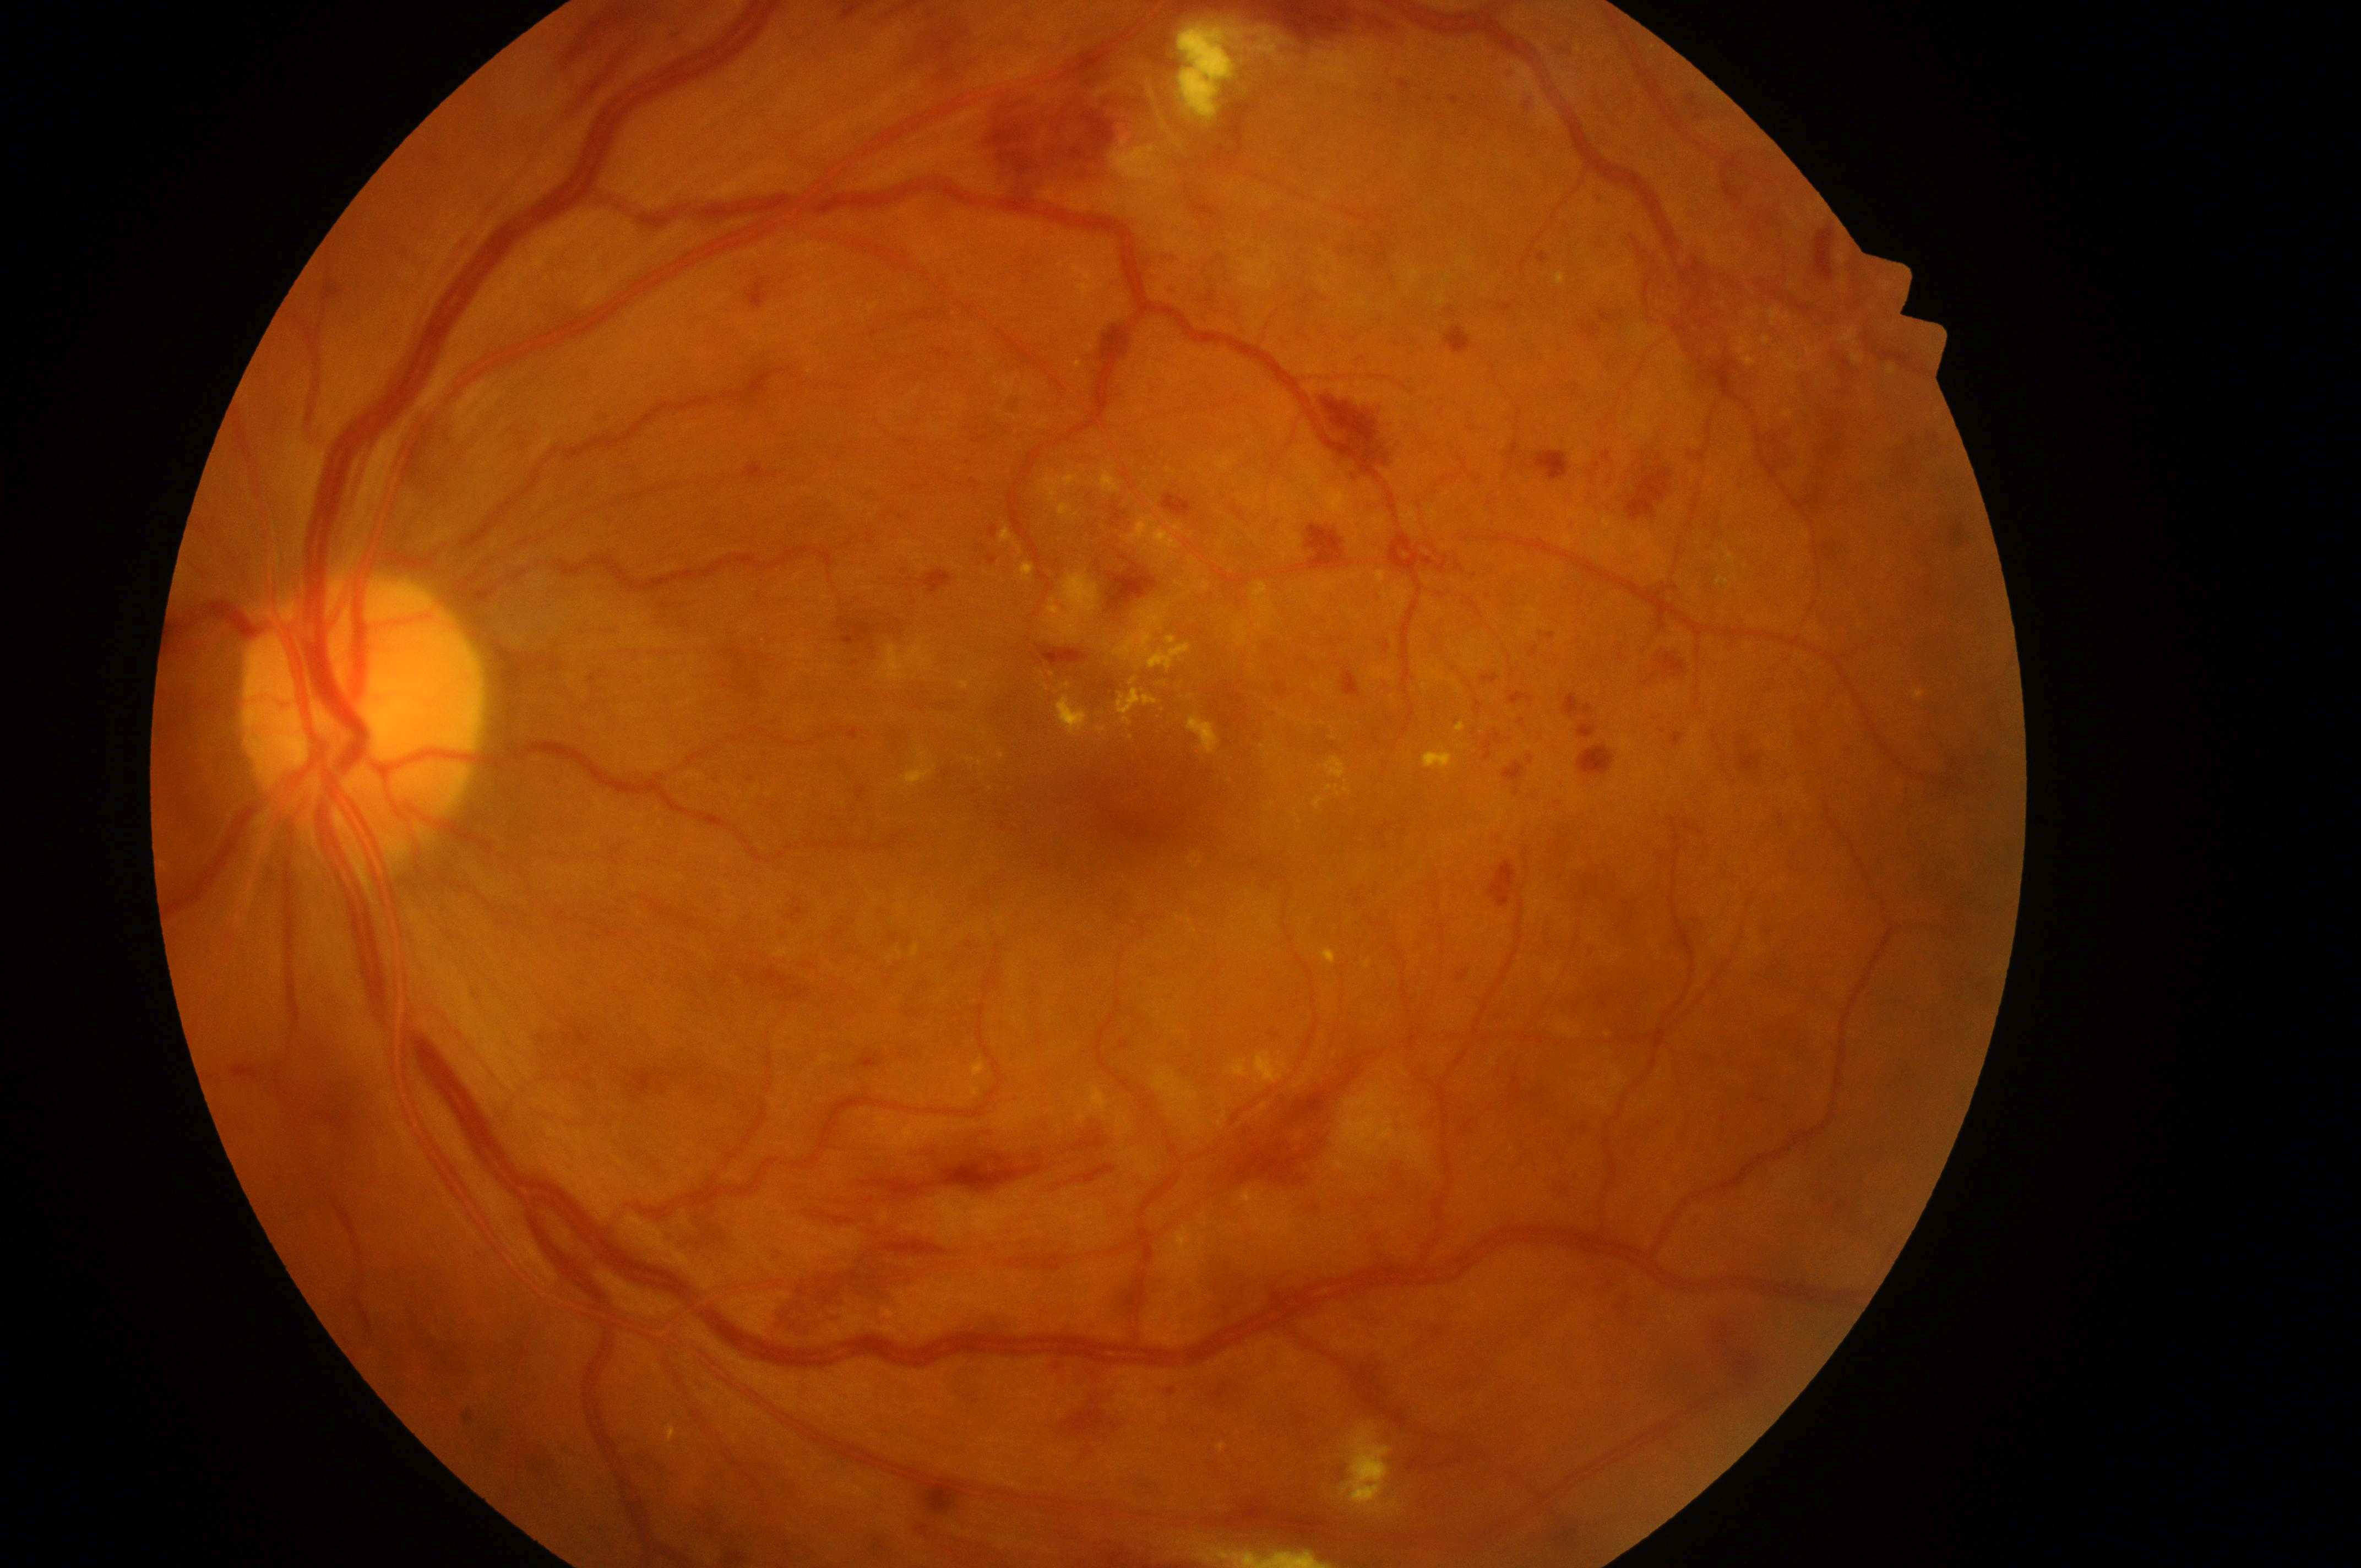
The macular center is at (x: 1134, y: 793). The optic disc is at (x: 356, y: 721). Diabetic retinopathy is grade 3 (severe NPDR). The image shows the left eye. The retinopathy is classified as non-proliferative diabetic retinopathy. Risk of macular edema: high risk (grade 2).